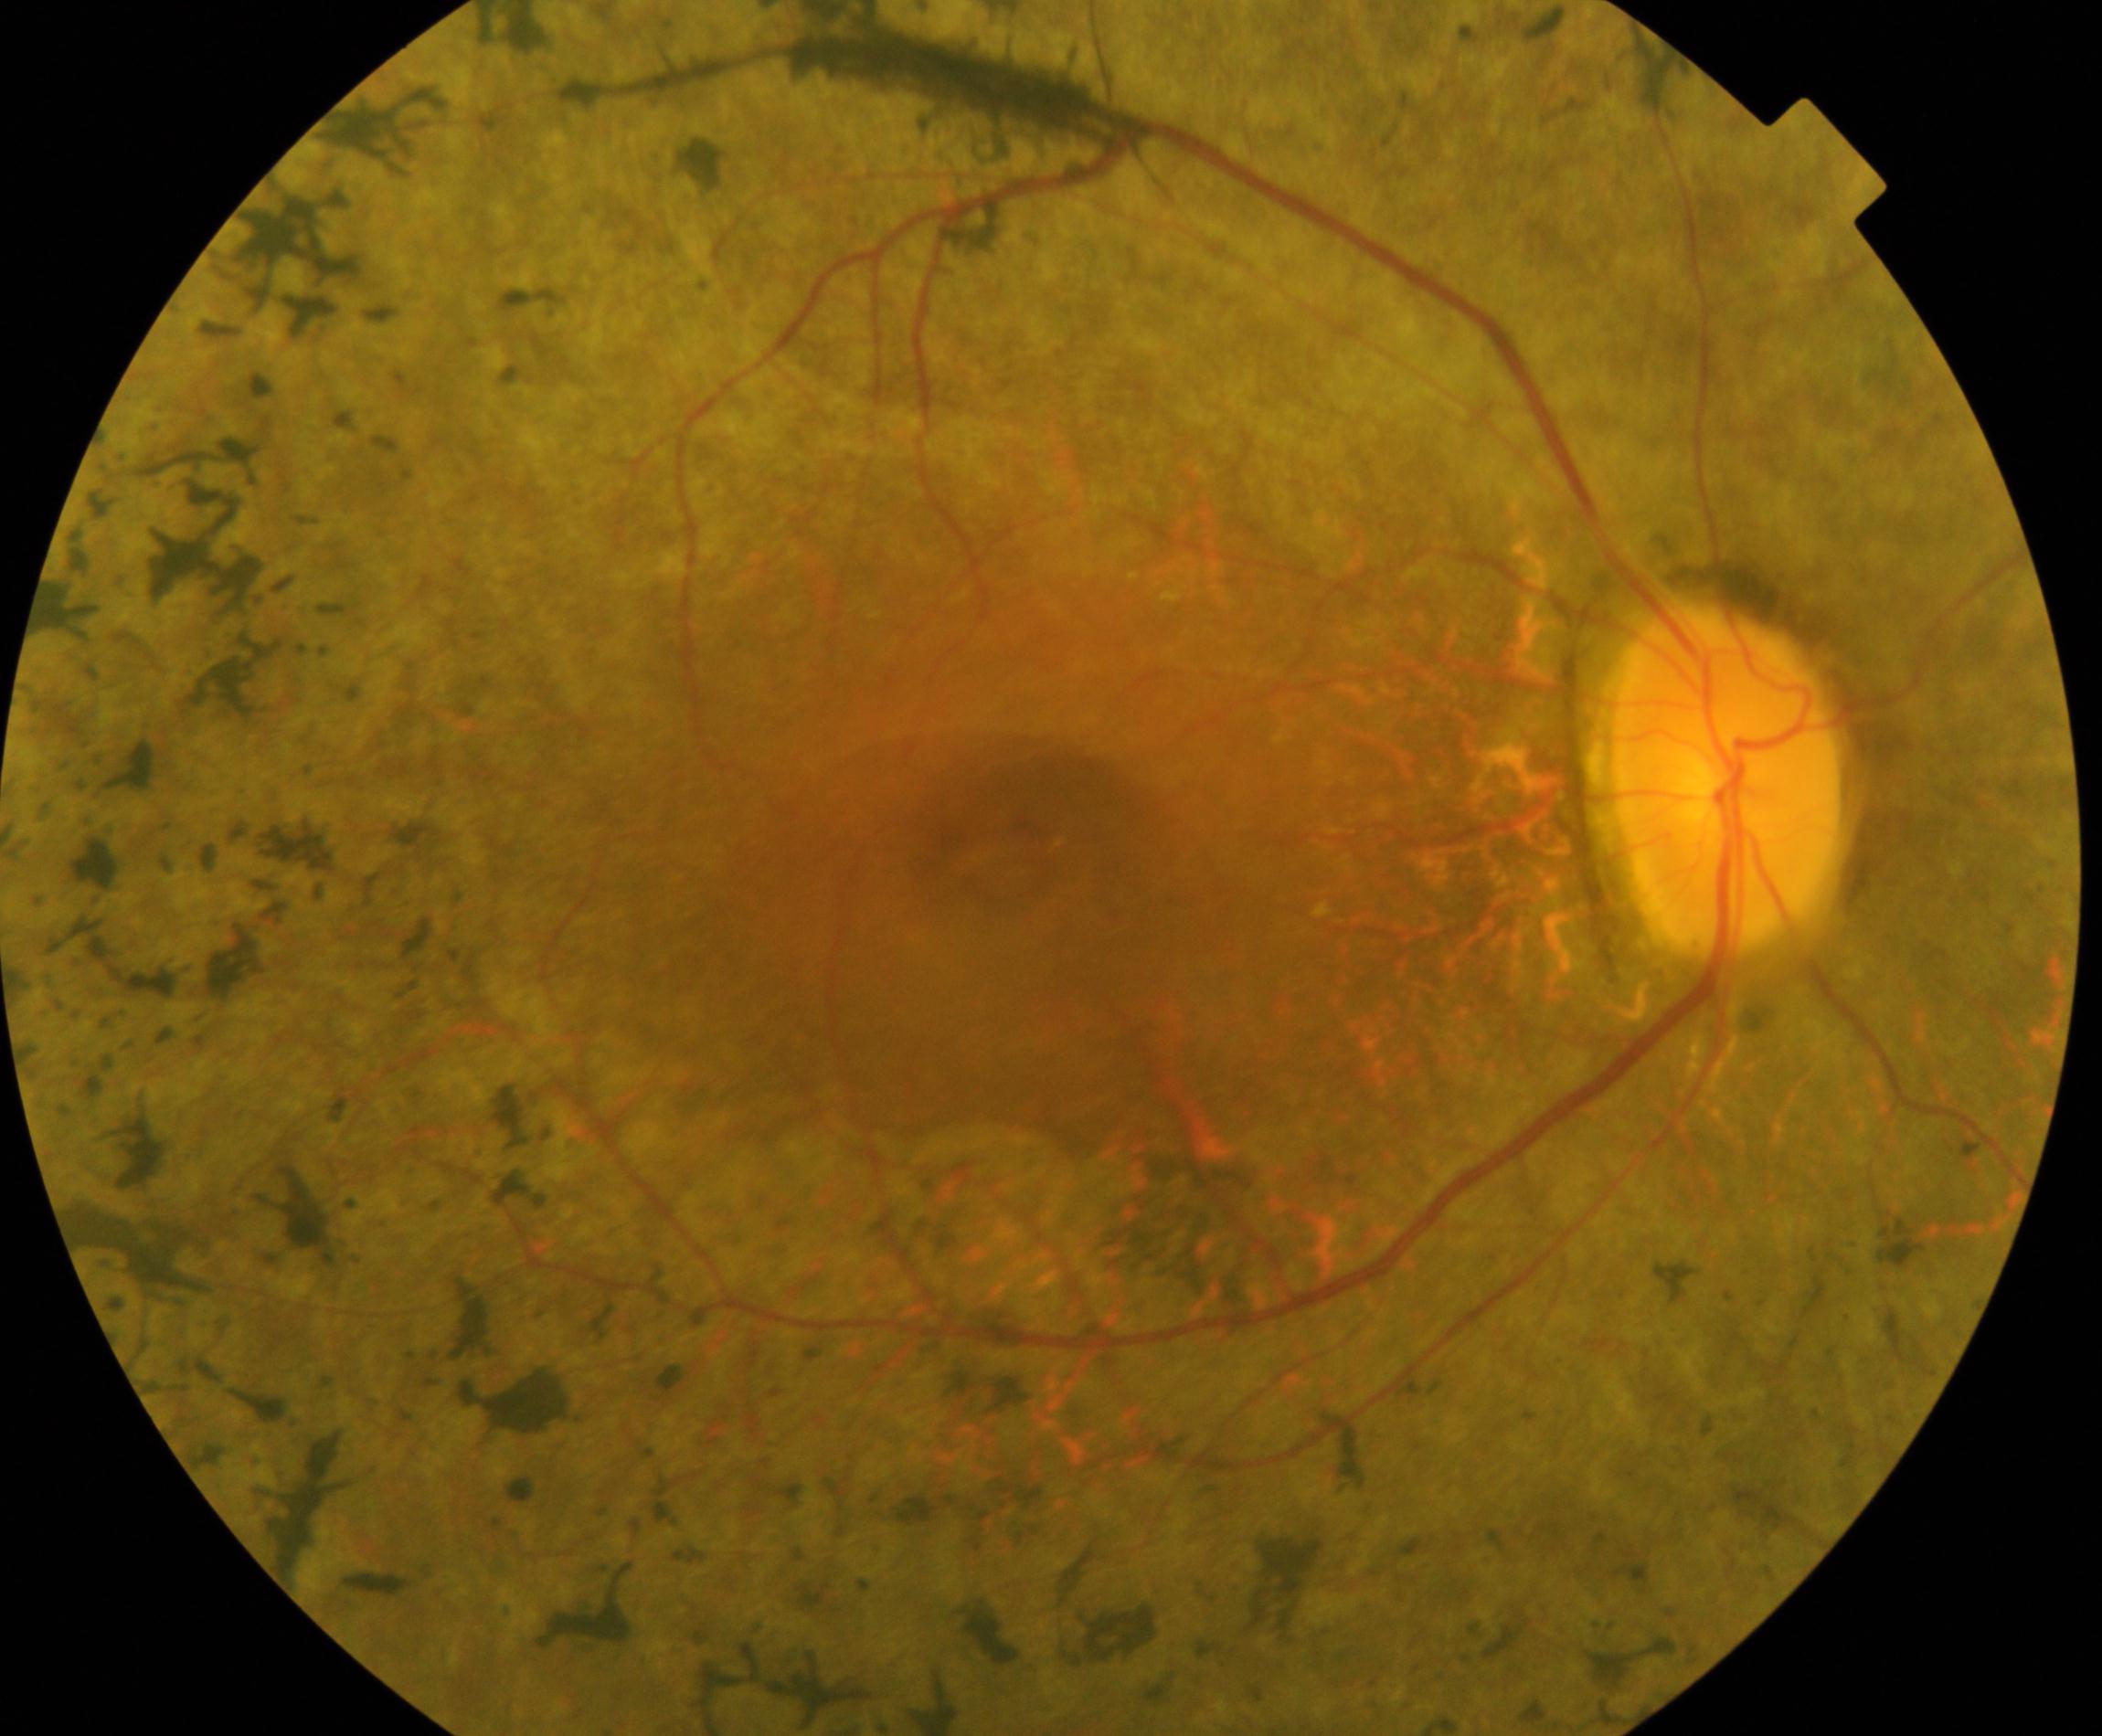 Classification: retinitis pigmentosa.